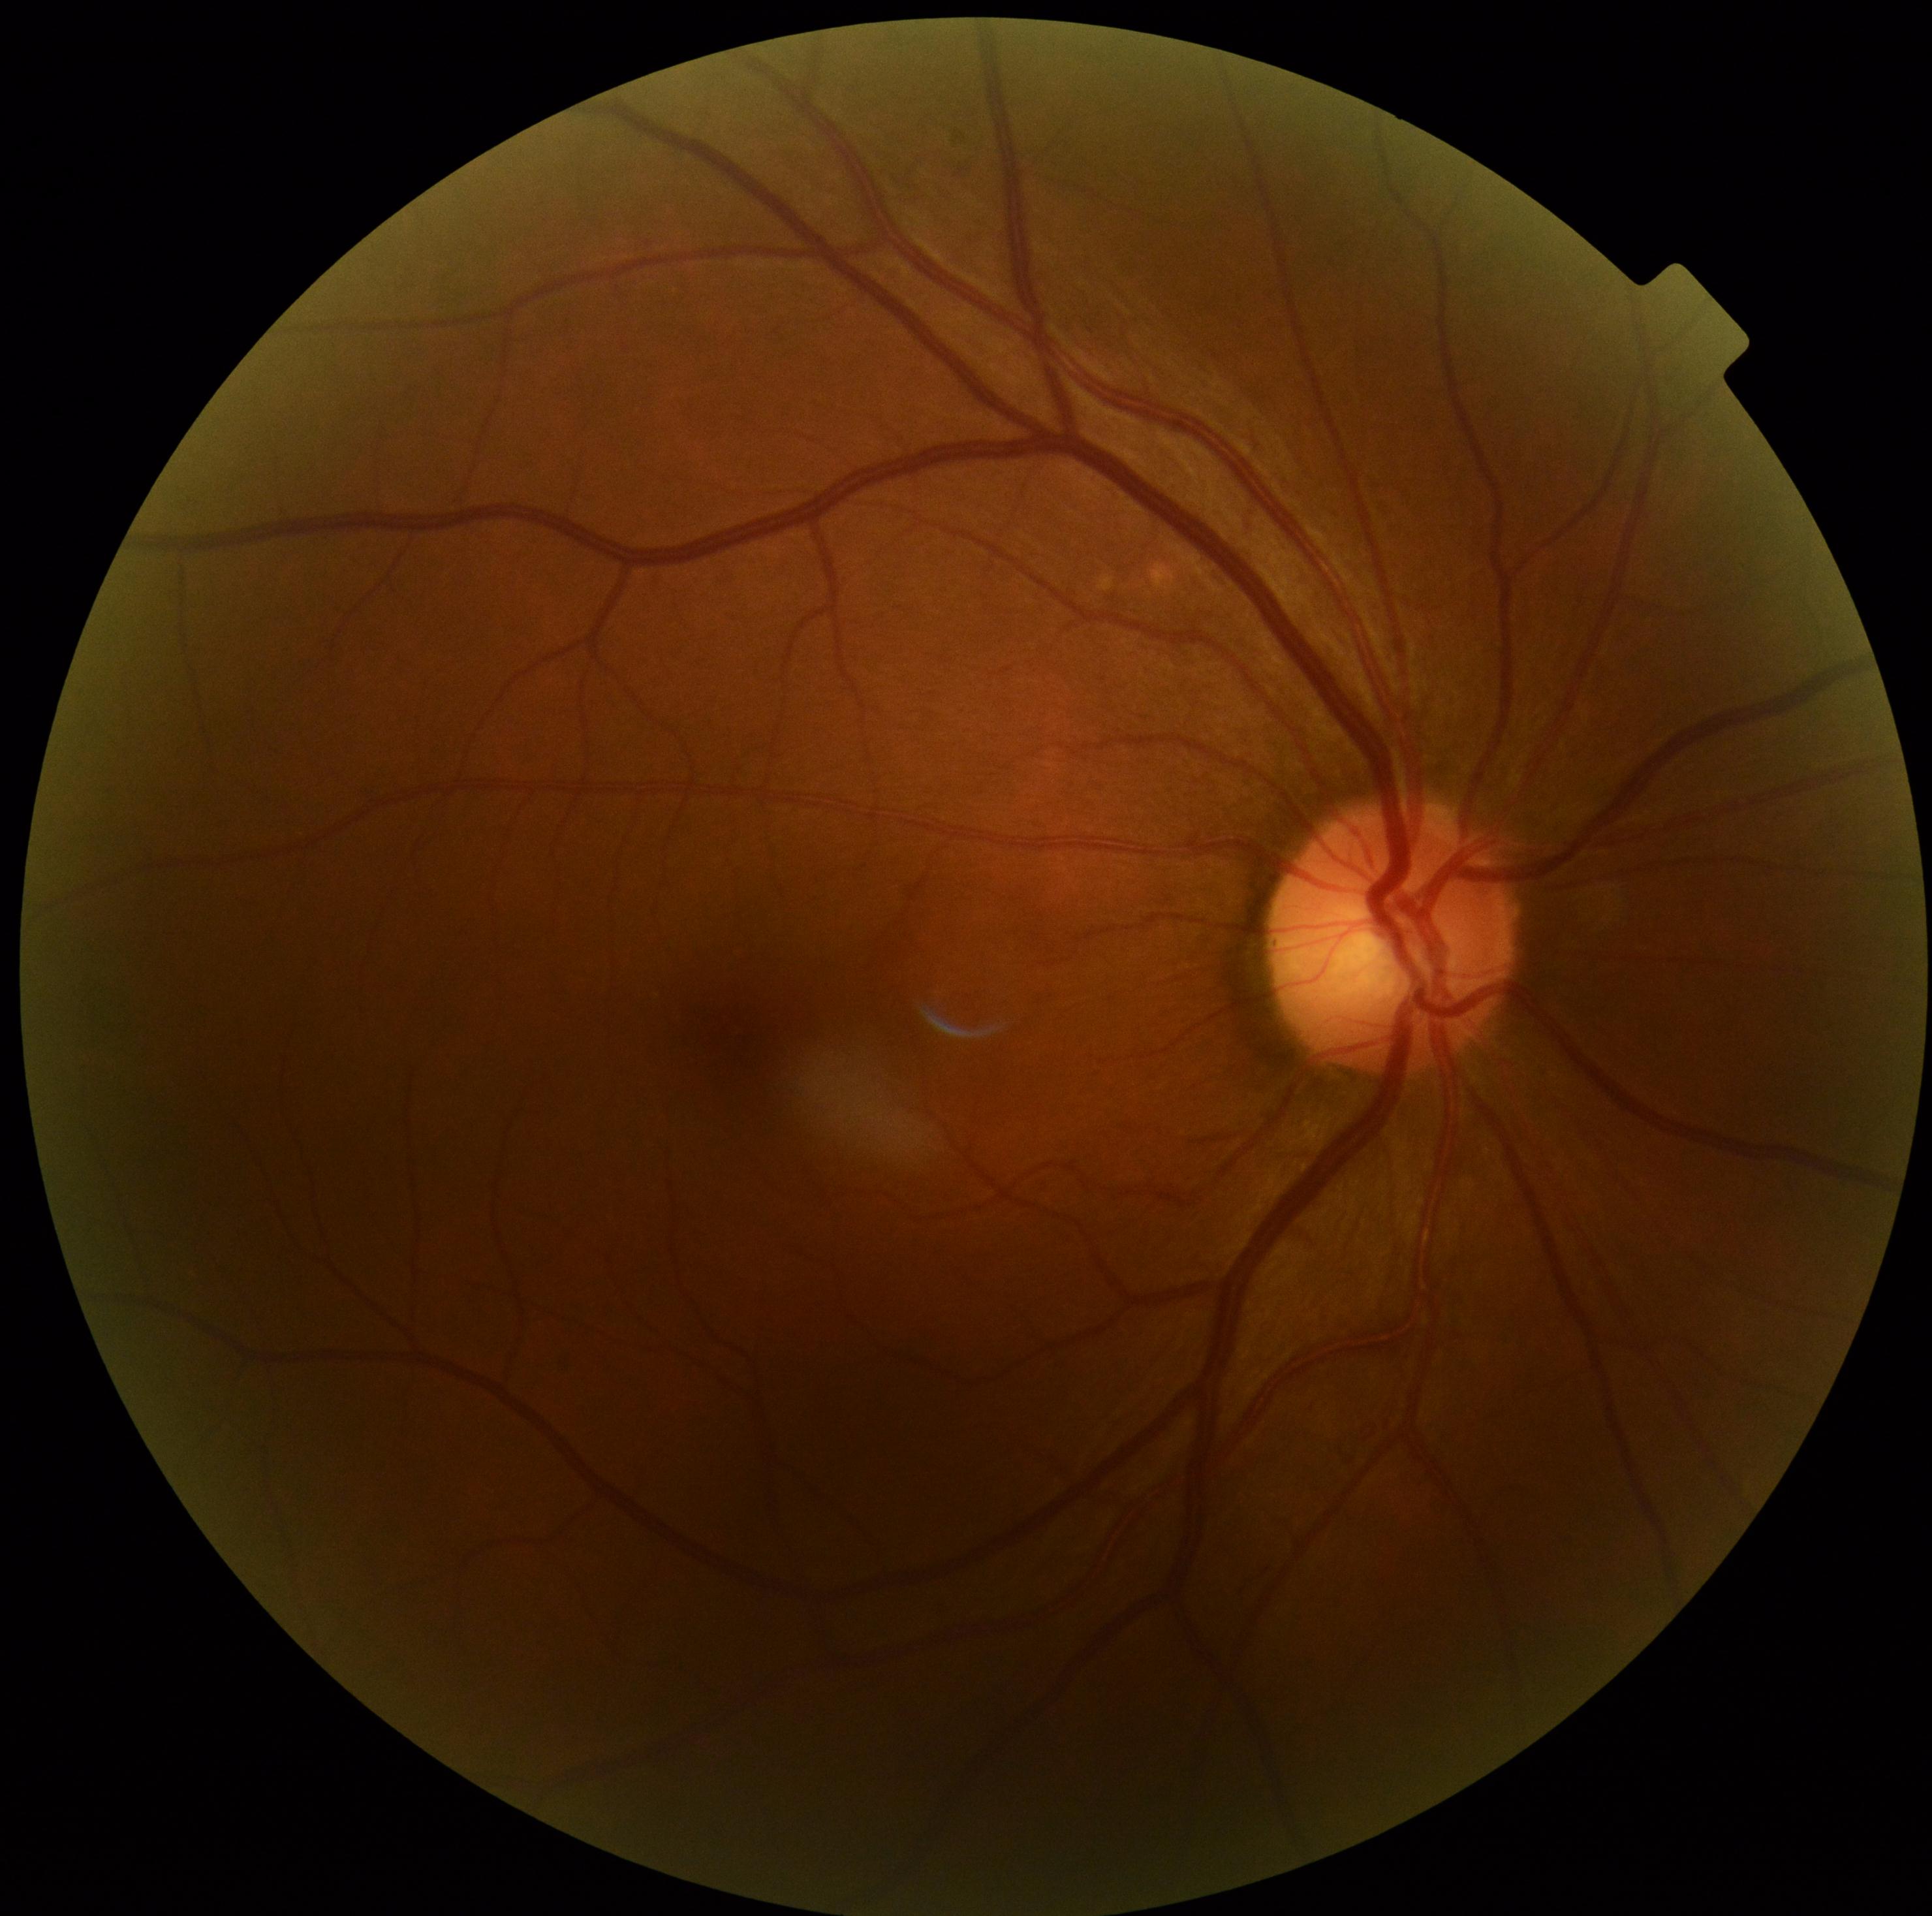
dr_impression: no signs of DR
dr_grade: no apparent retinopathy (grade 0) — no visible signs of diabetic retinopathy